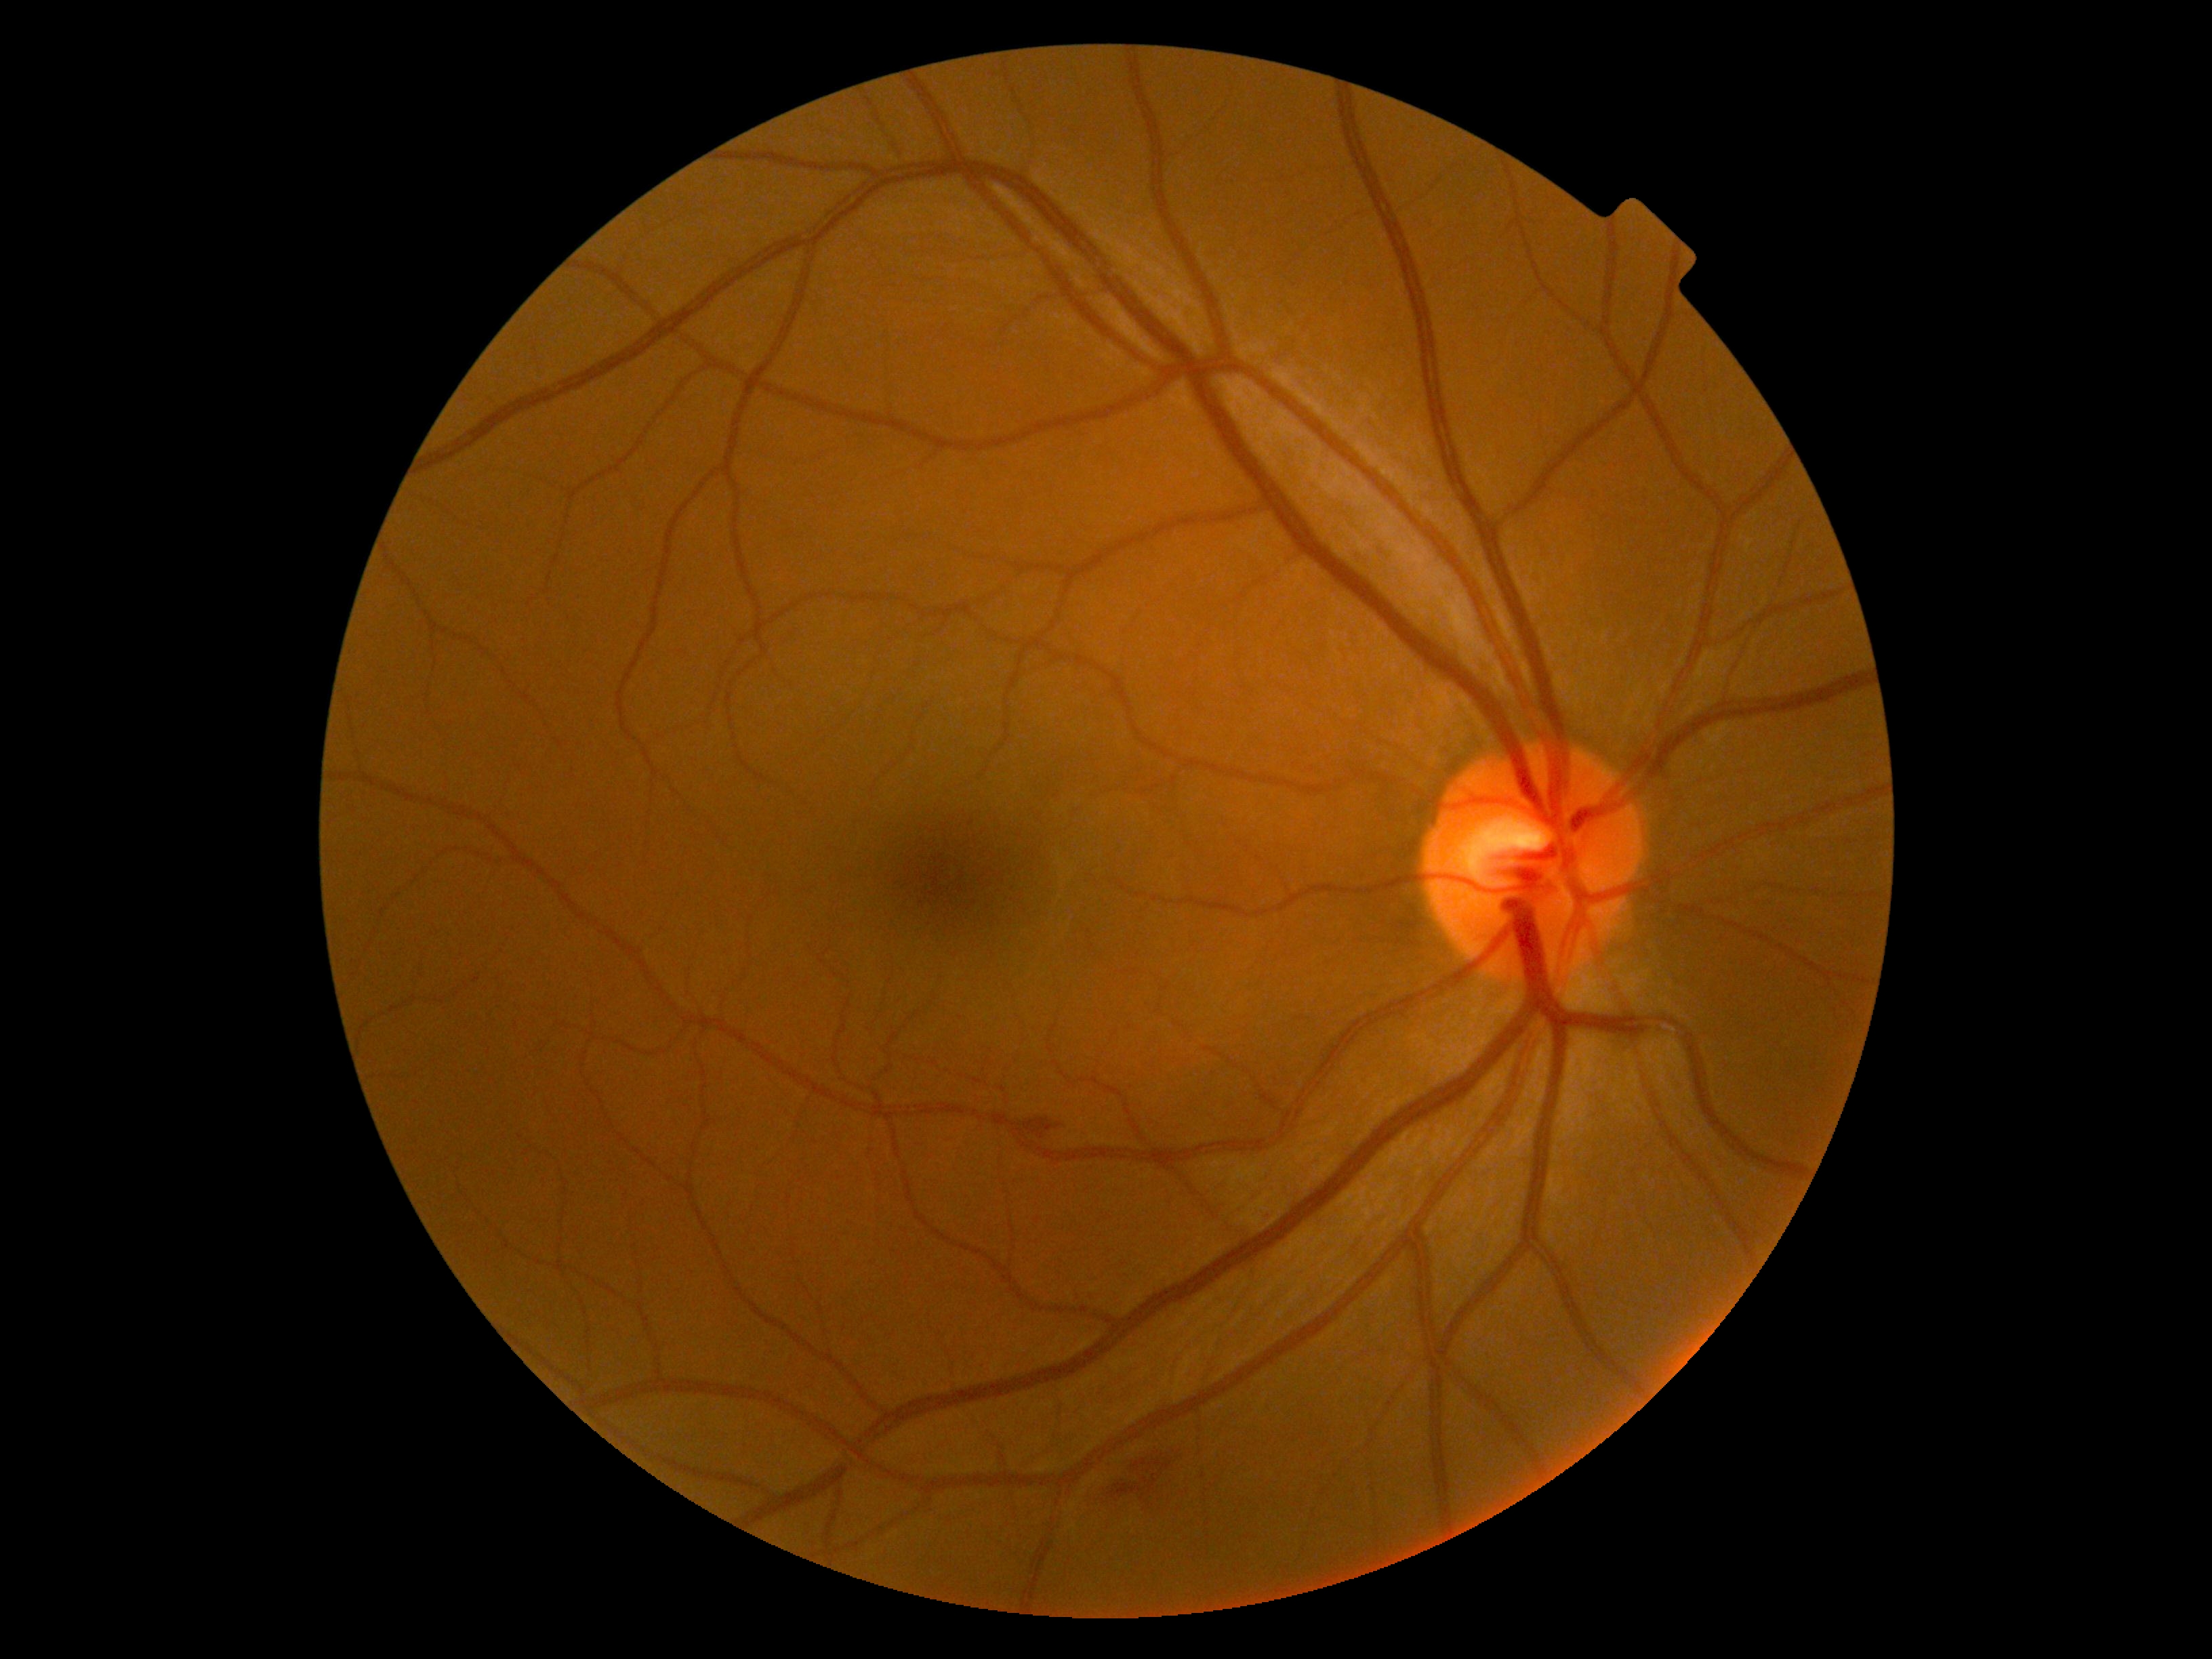
Diabetic retinopathy (DR) is moderate NPDR (grade 2).